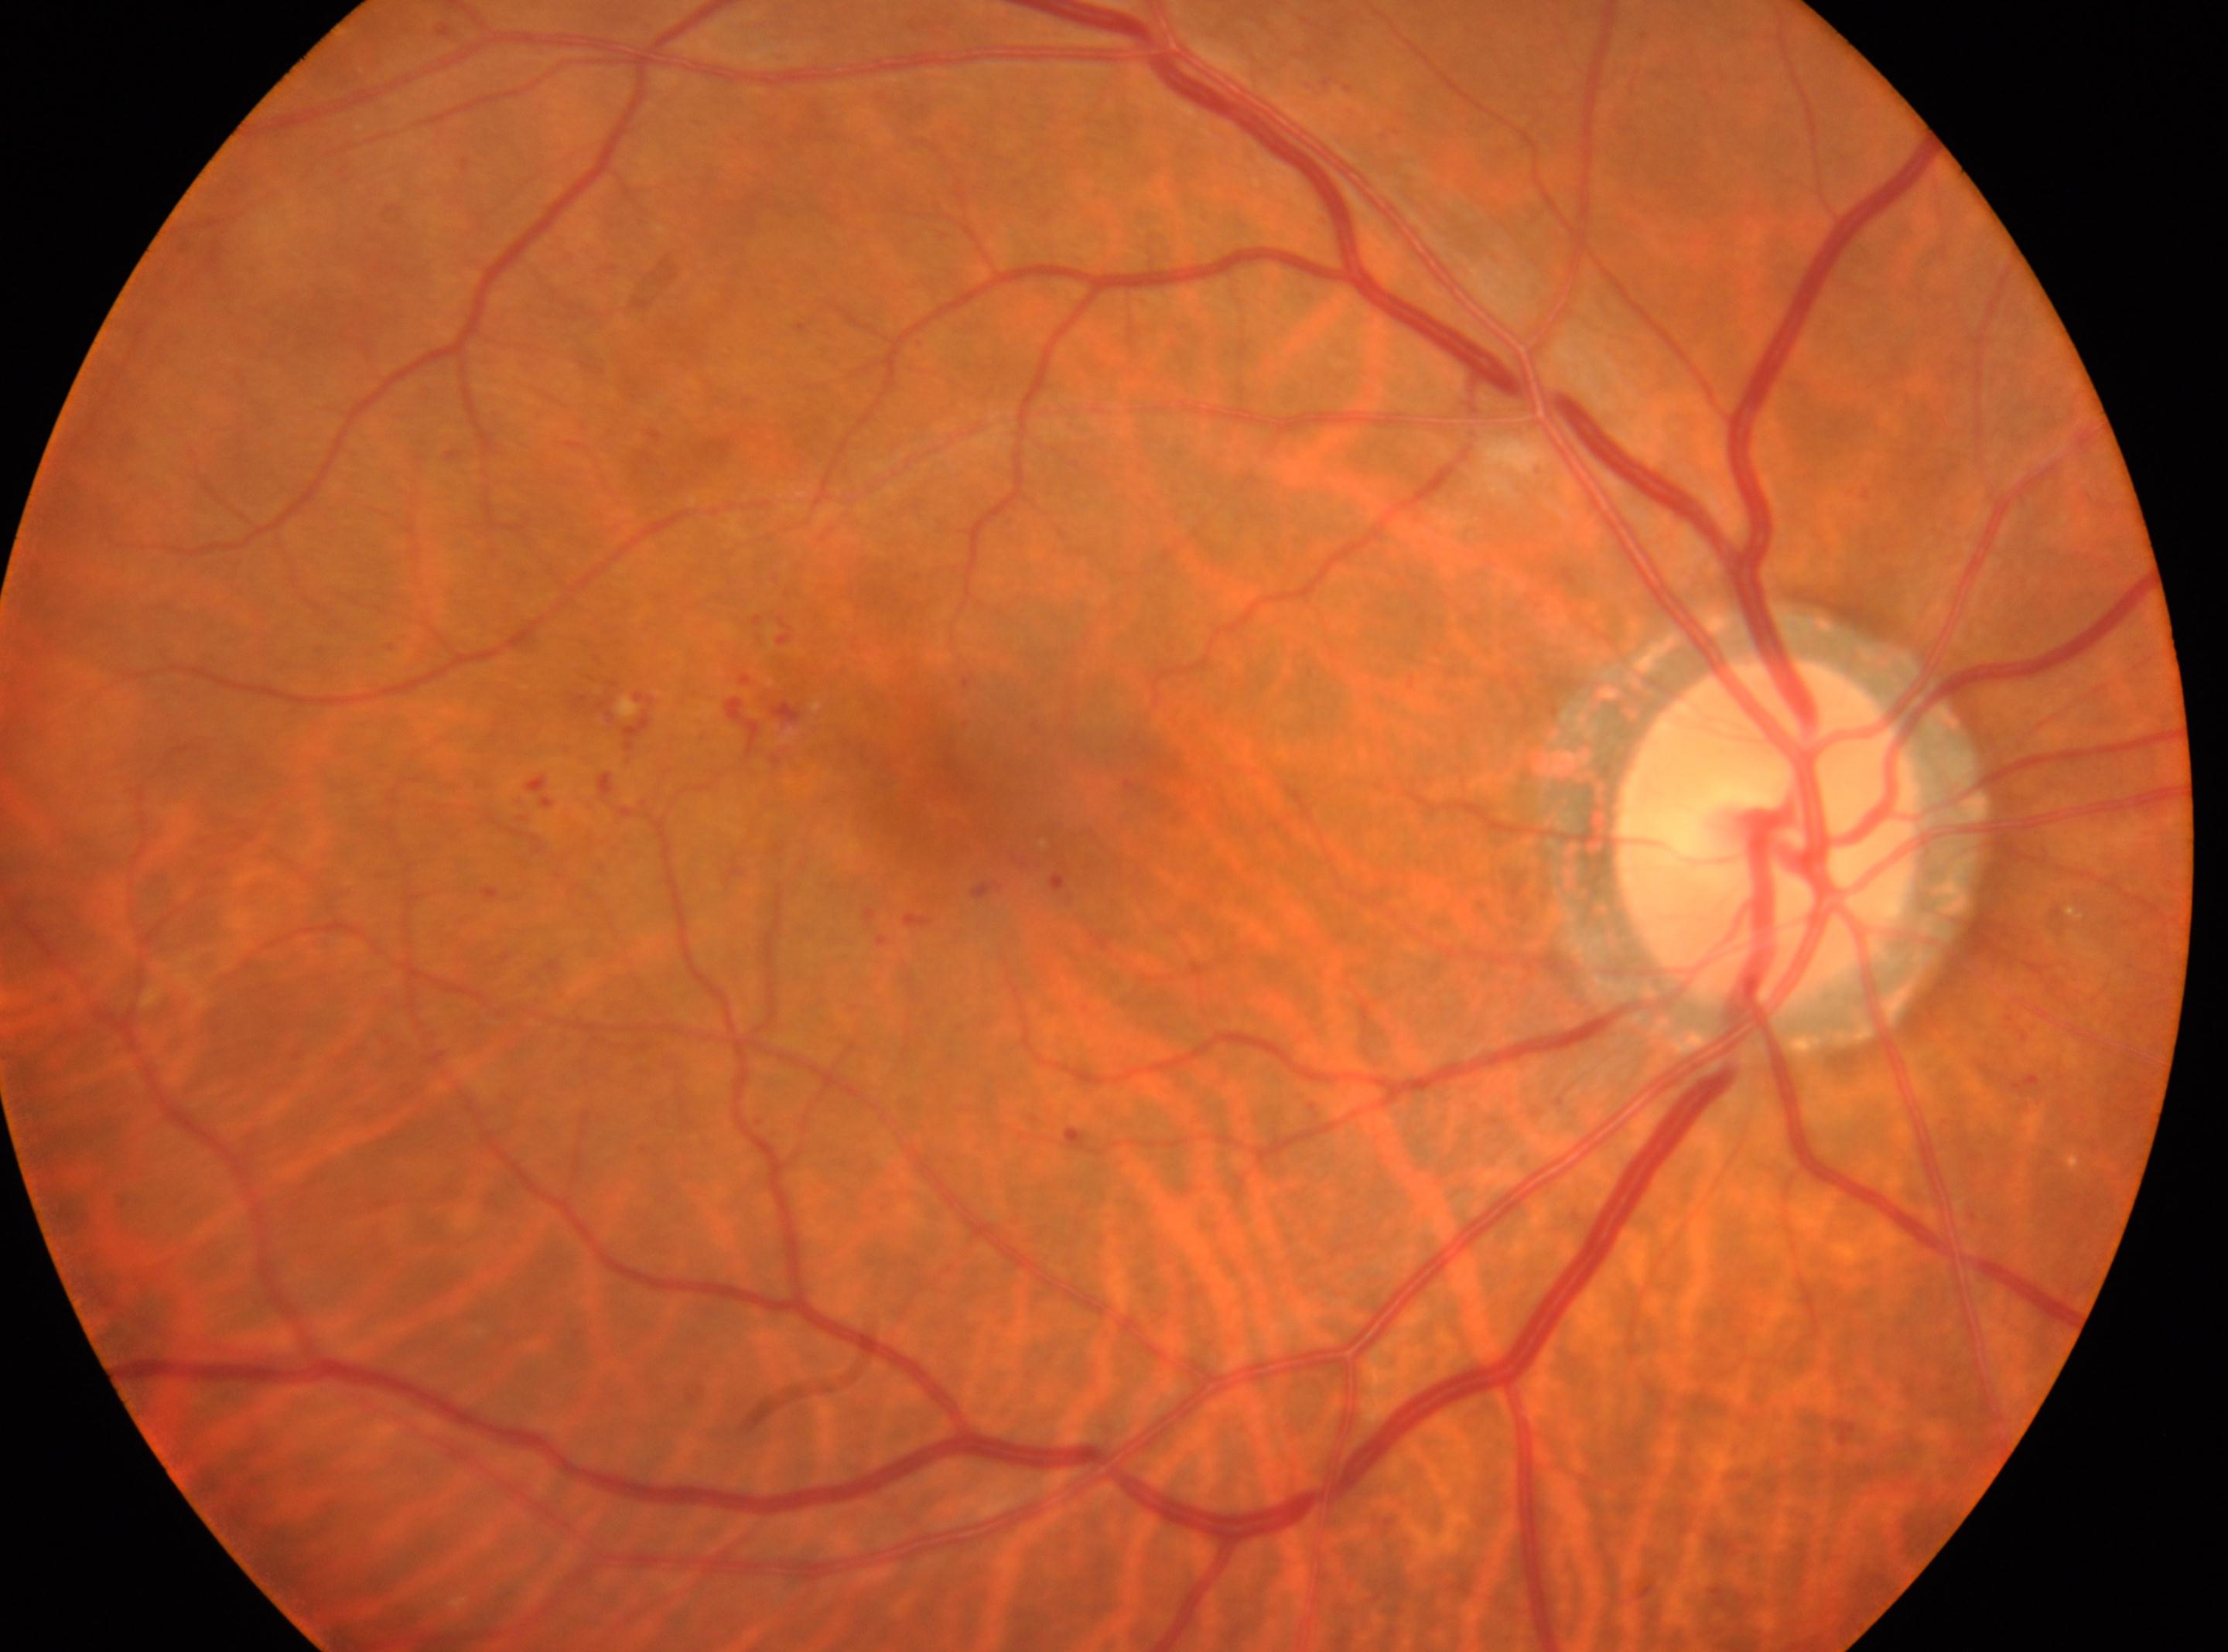
The optic disc center is at x=1767, y=834. DR is moderate non-proliferative diabetic retinopathy (grade 2). Fovea located at x=973, y=786. This is the right eye.